Image size 2184x1690; color fundus photograph.
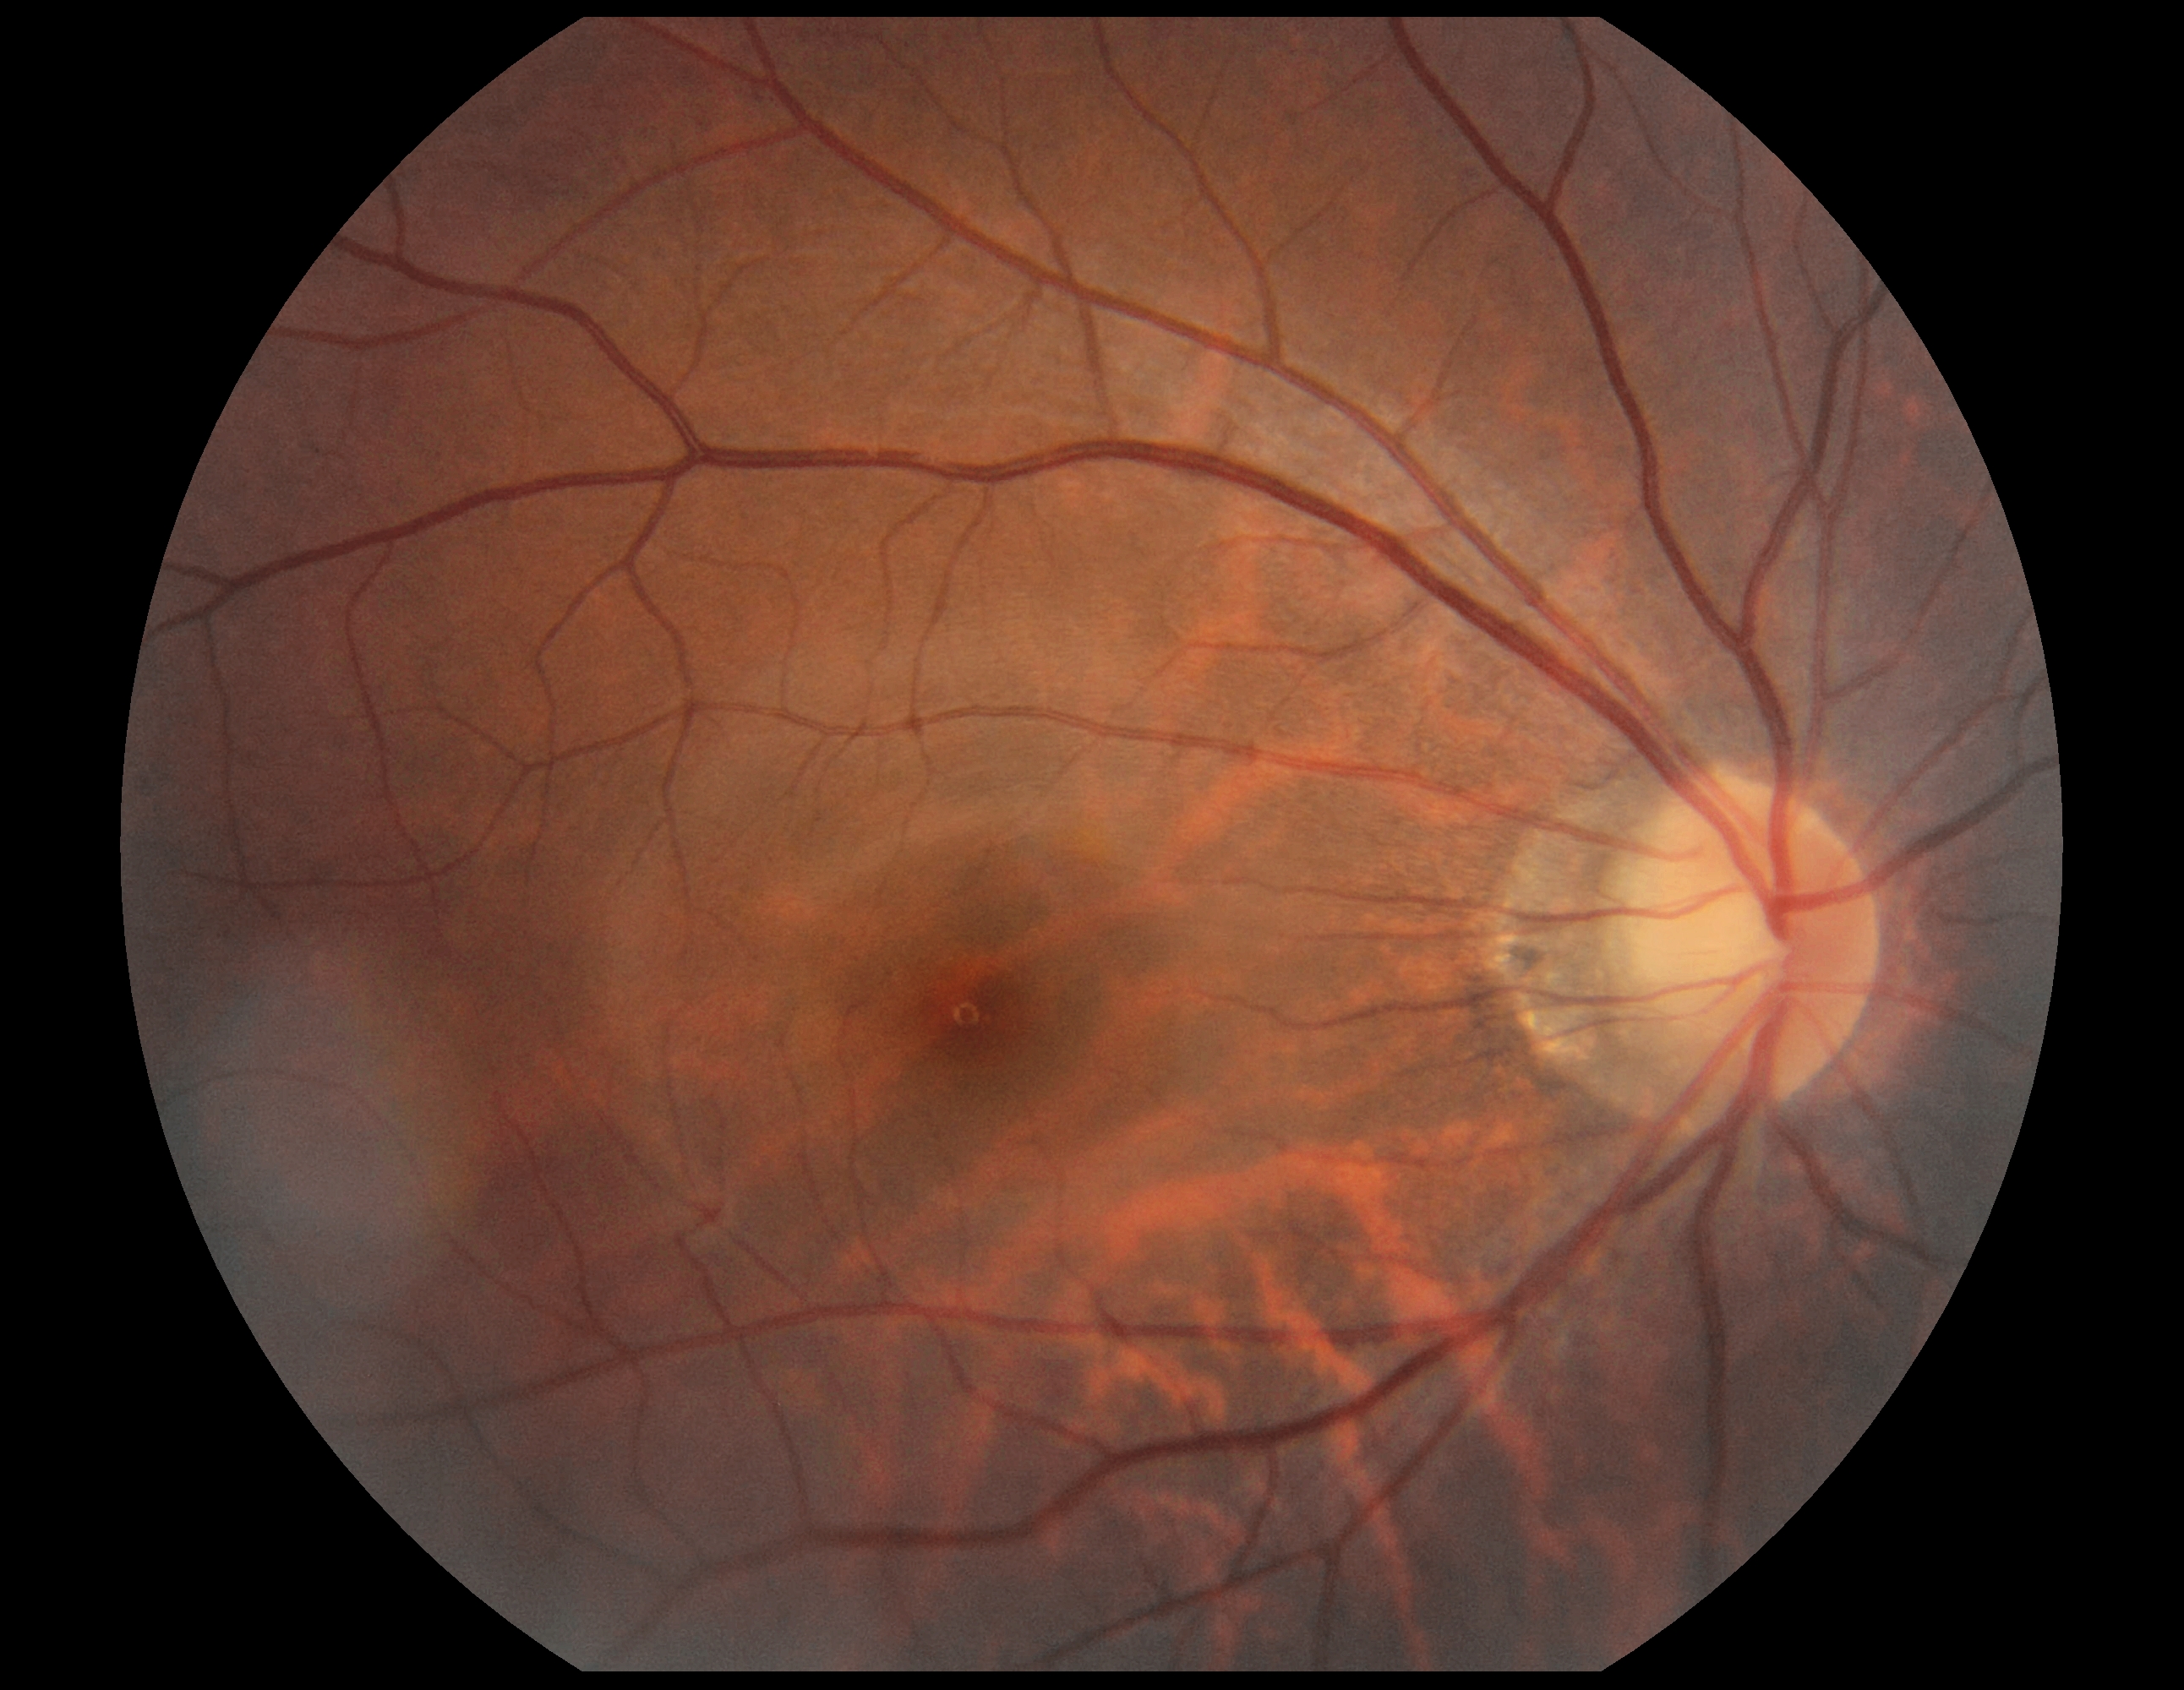
diabetic retinopathy grade: no apparent retinopathy (0).